Fundus photo · image size 848x848 · NIDEK AFC-230 fundus camera · without pupil dilation — 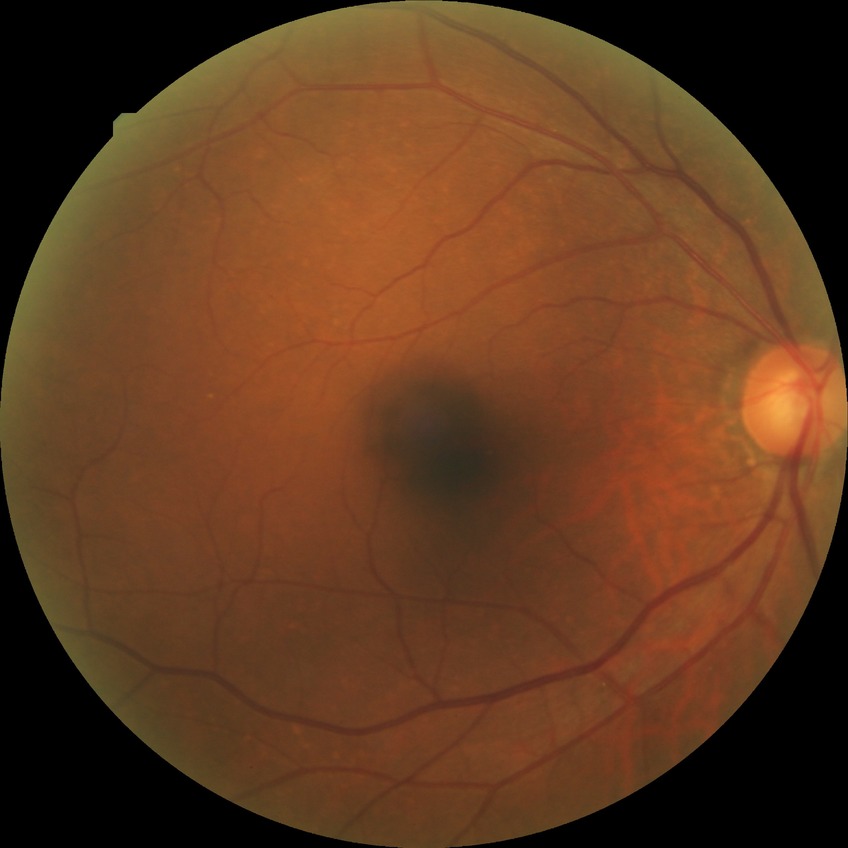 DR severity: NDR; DR impression: no DR findings.